FOV: 45 degrees; CFP: 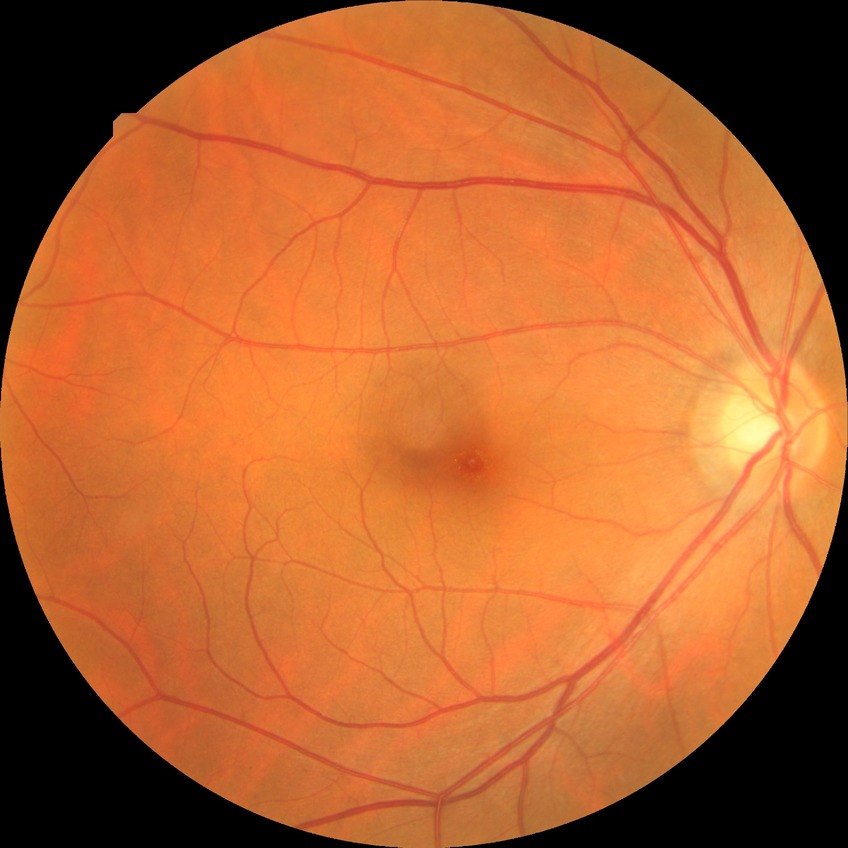 diabetic retinopathy (DR) = NDR (no diabetic retinopathy).